Pediatric retinal photograph (wide-field); image size 640x480; Clarity RetCam 3, 130° FOV — 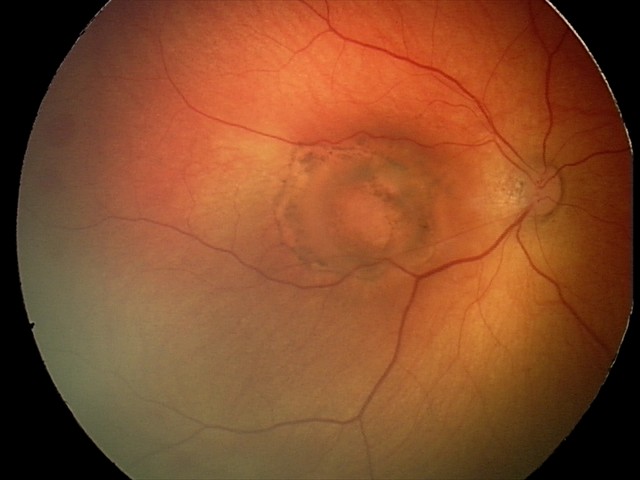 Assessment: toxoplasmosis chorioretinitis.